130° field of view (Clarity RetCam 3). Infant wide-field retinal image
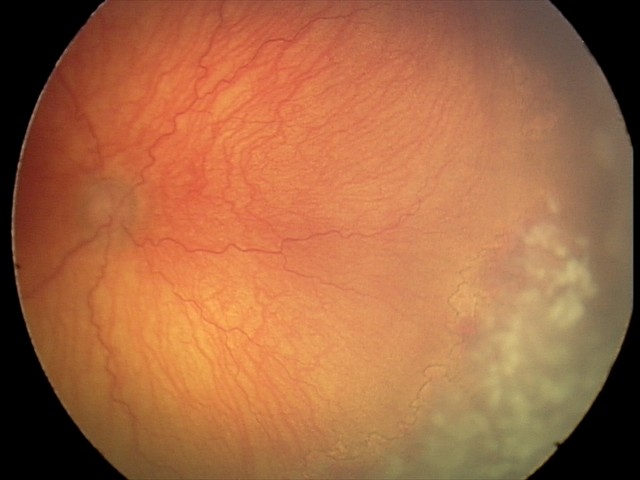
Q: What is the screening diagnosis?
A: aggressive retinopathy of prematurity (A-ROP)